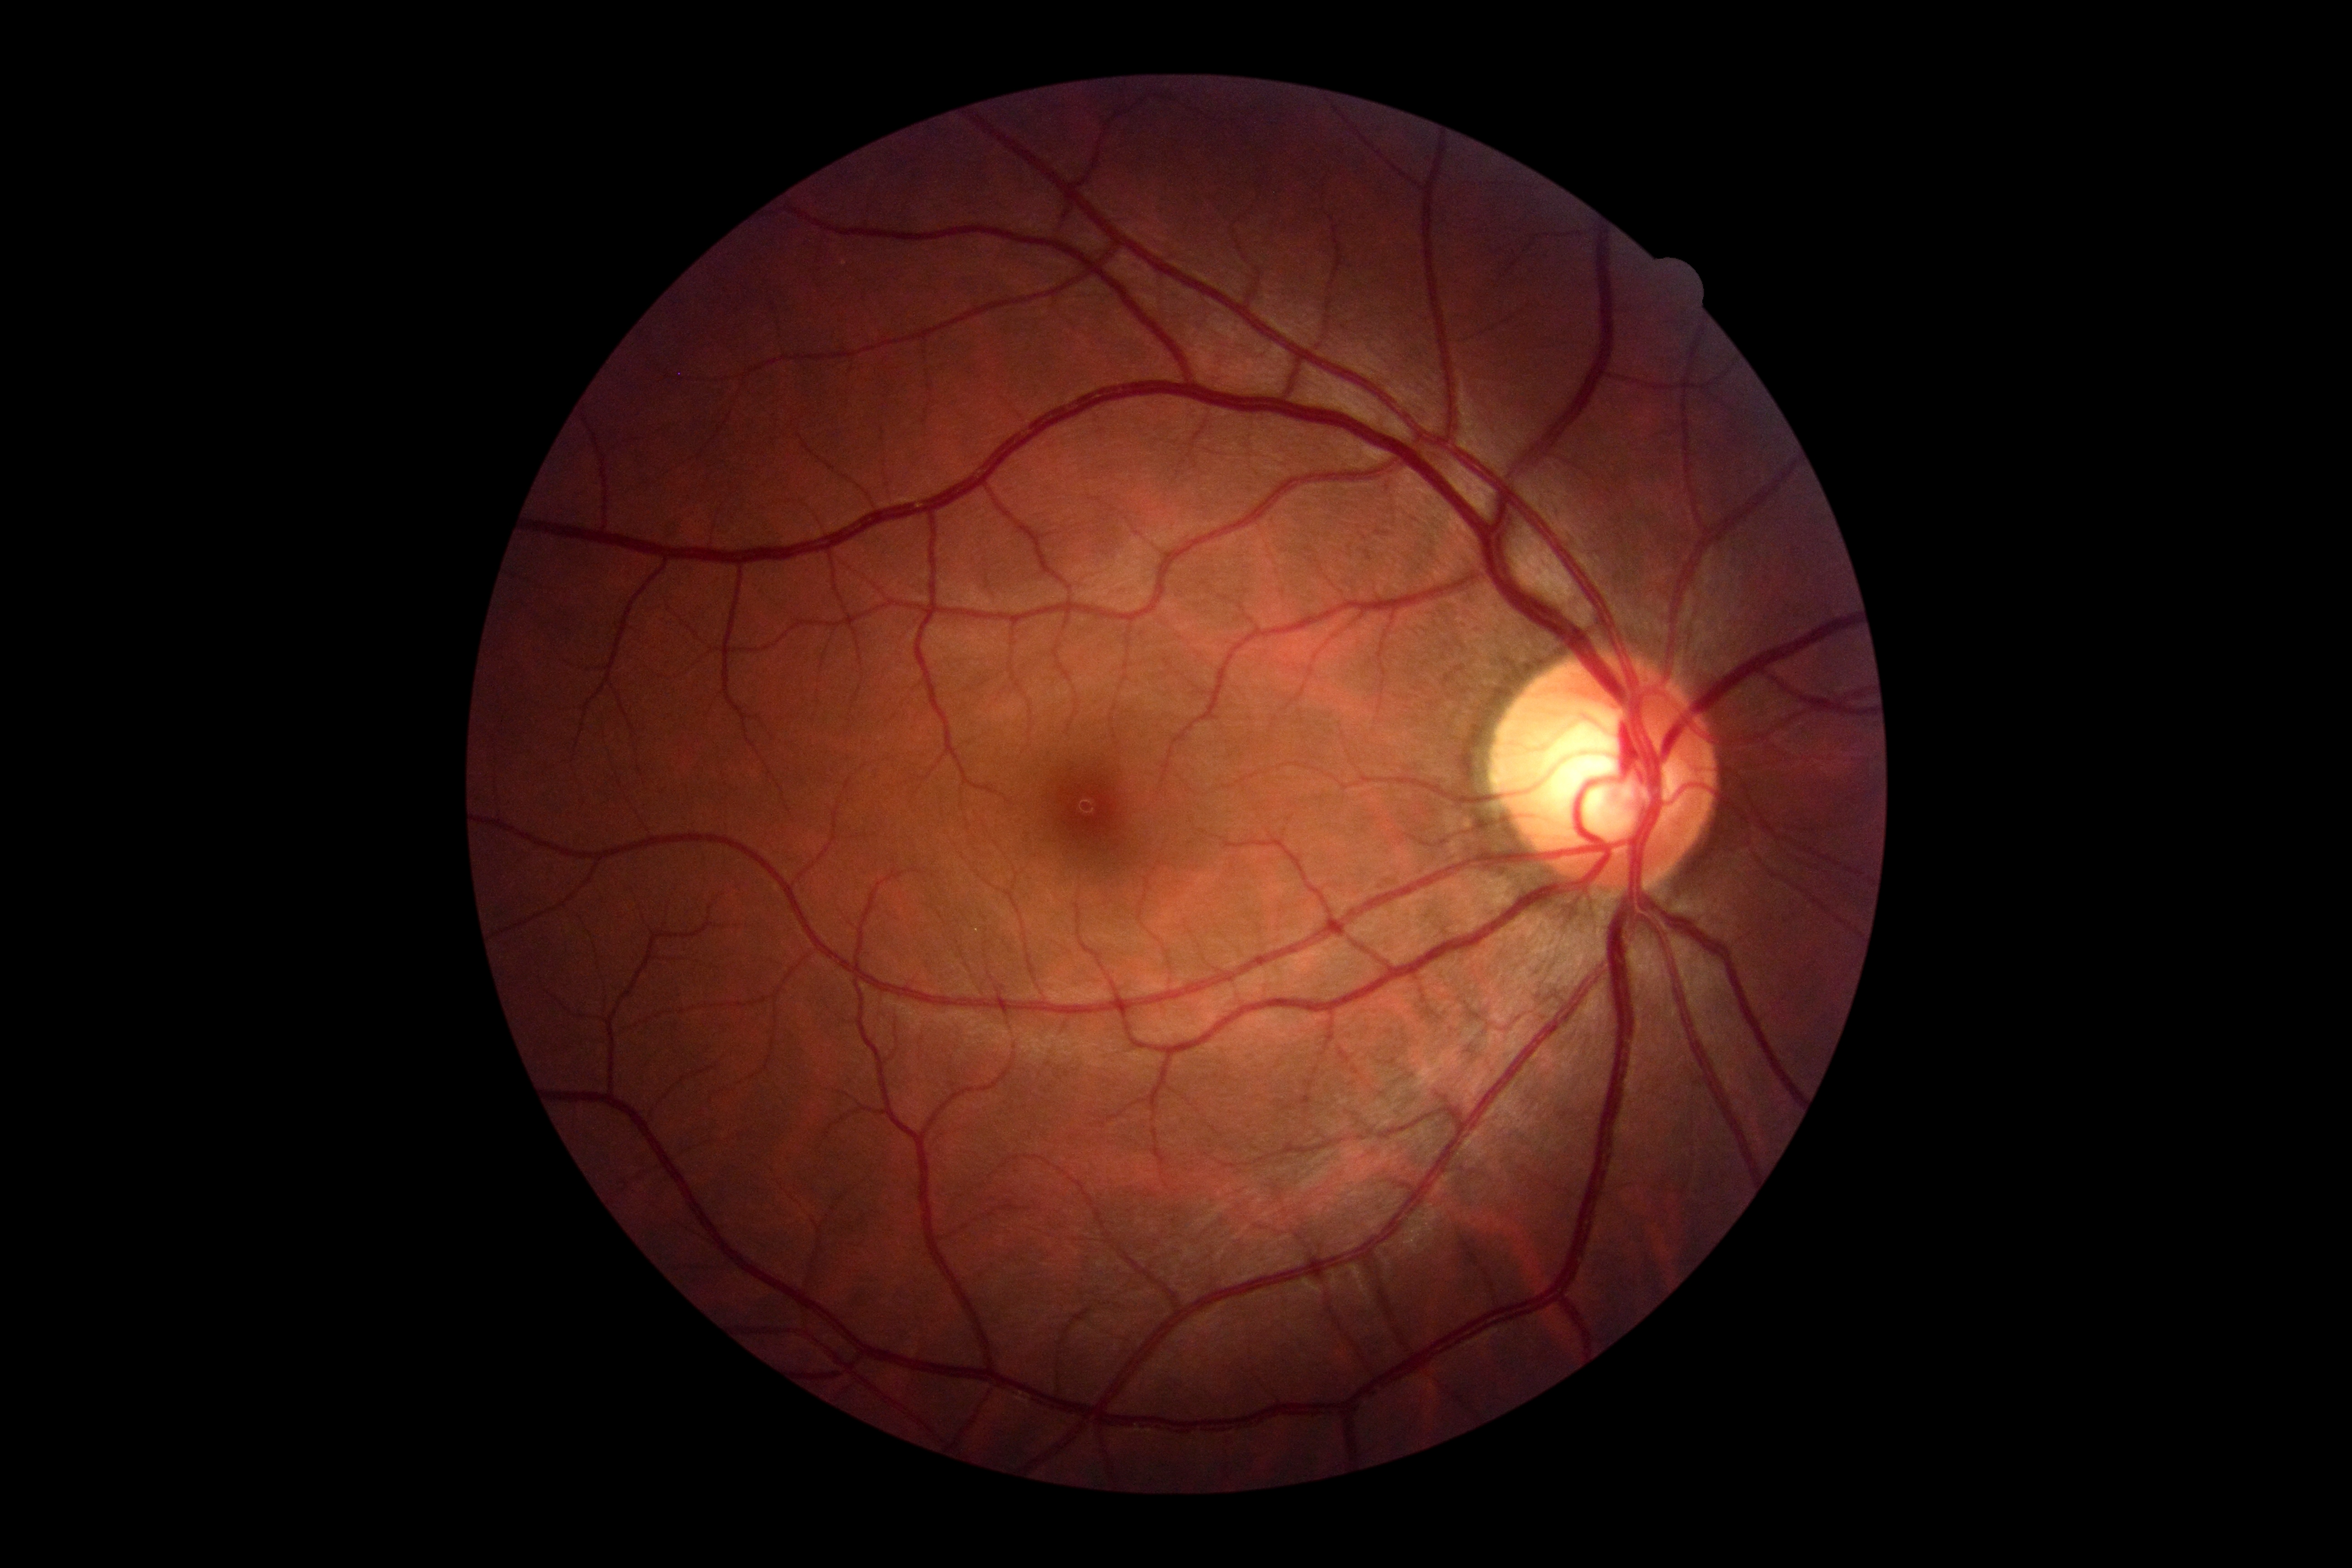 diabetic retinopathy (DR): grade 0 (no apparent retinopathy).